Age 58; central corneal thickness 553 µm; axial length (AL) 22.57 mm.
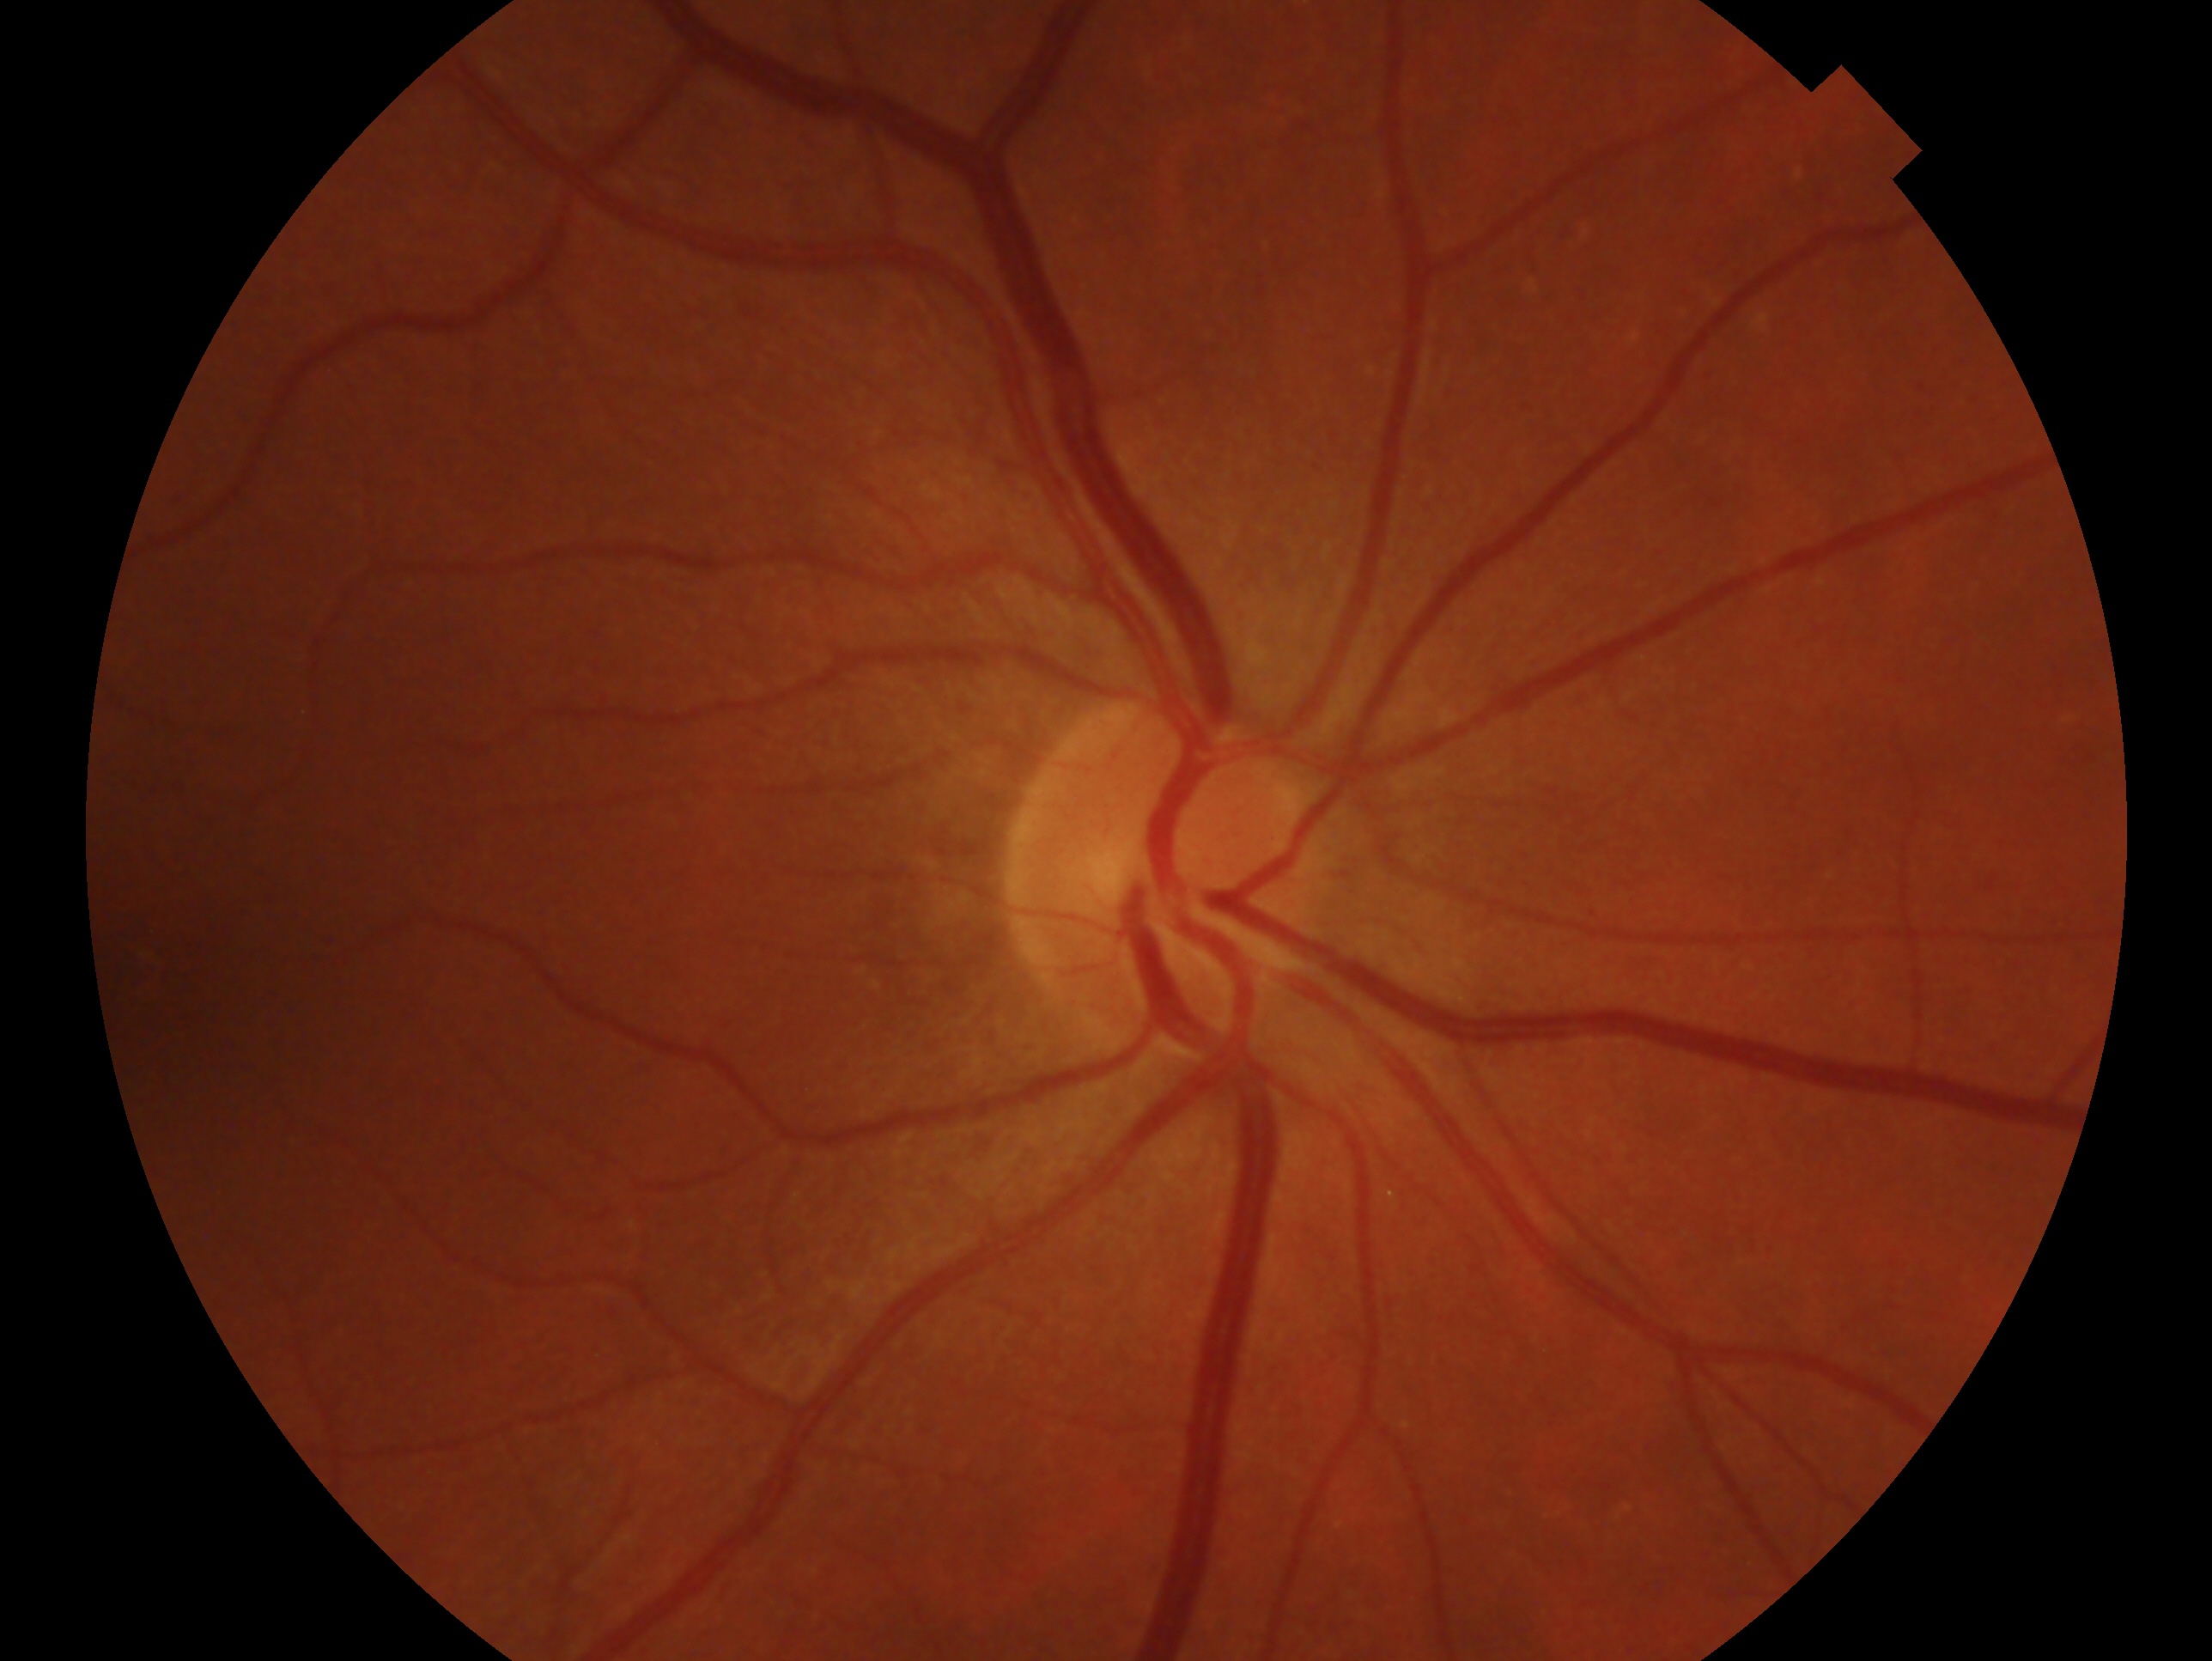 assessment=no evidence of glaucoma | laterality=right eye.